Color fundus image, 2361x1568px, macula-centered, FOV: 50 degrees — 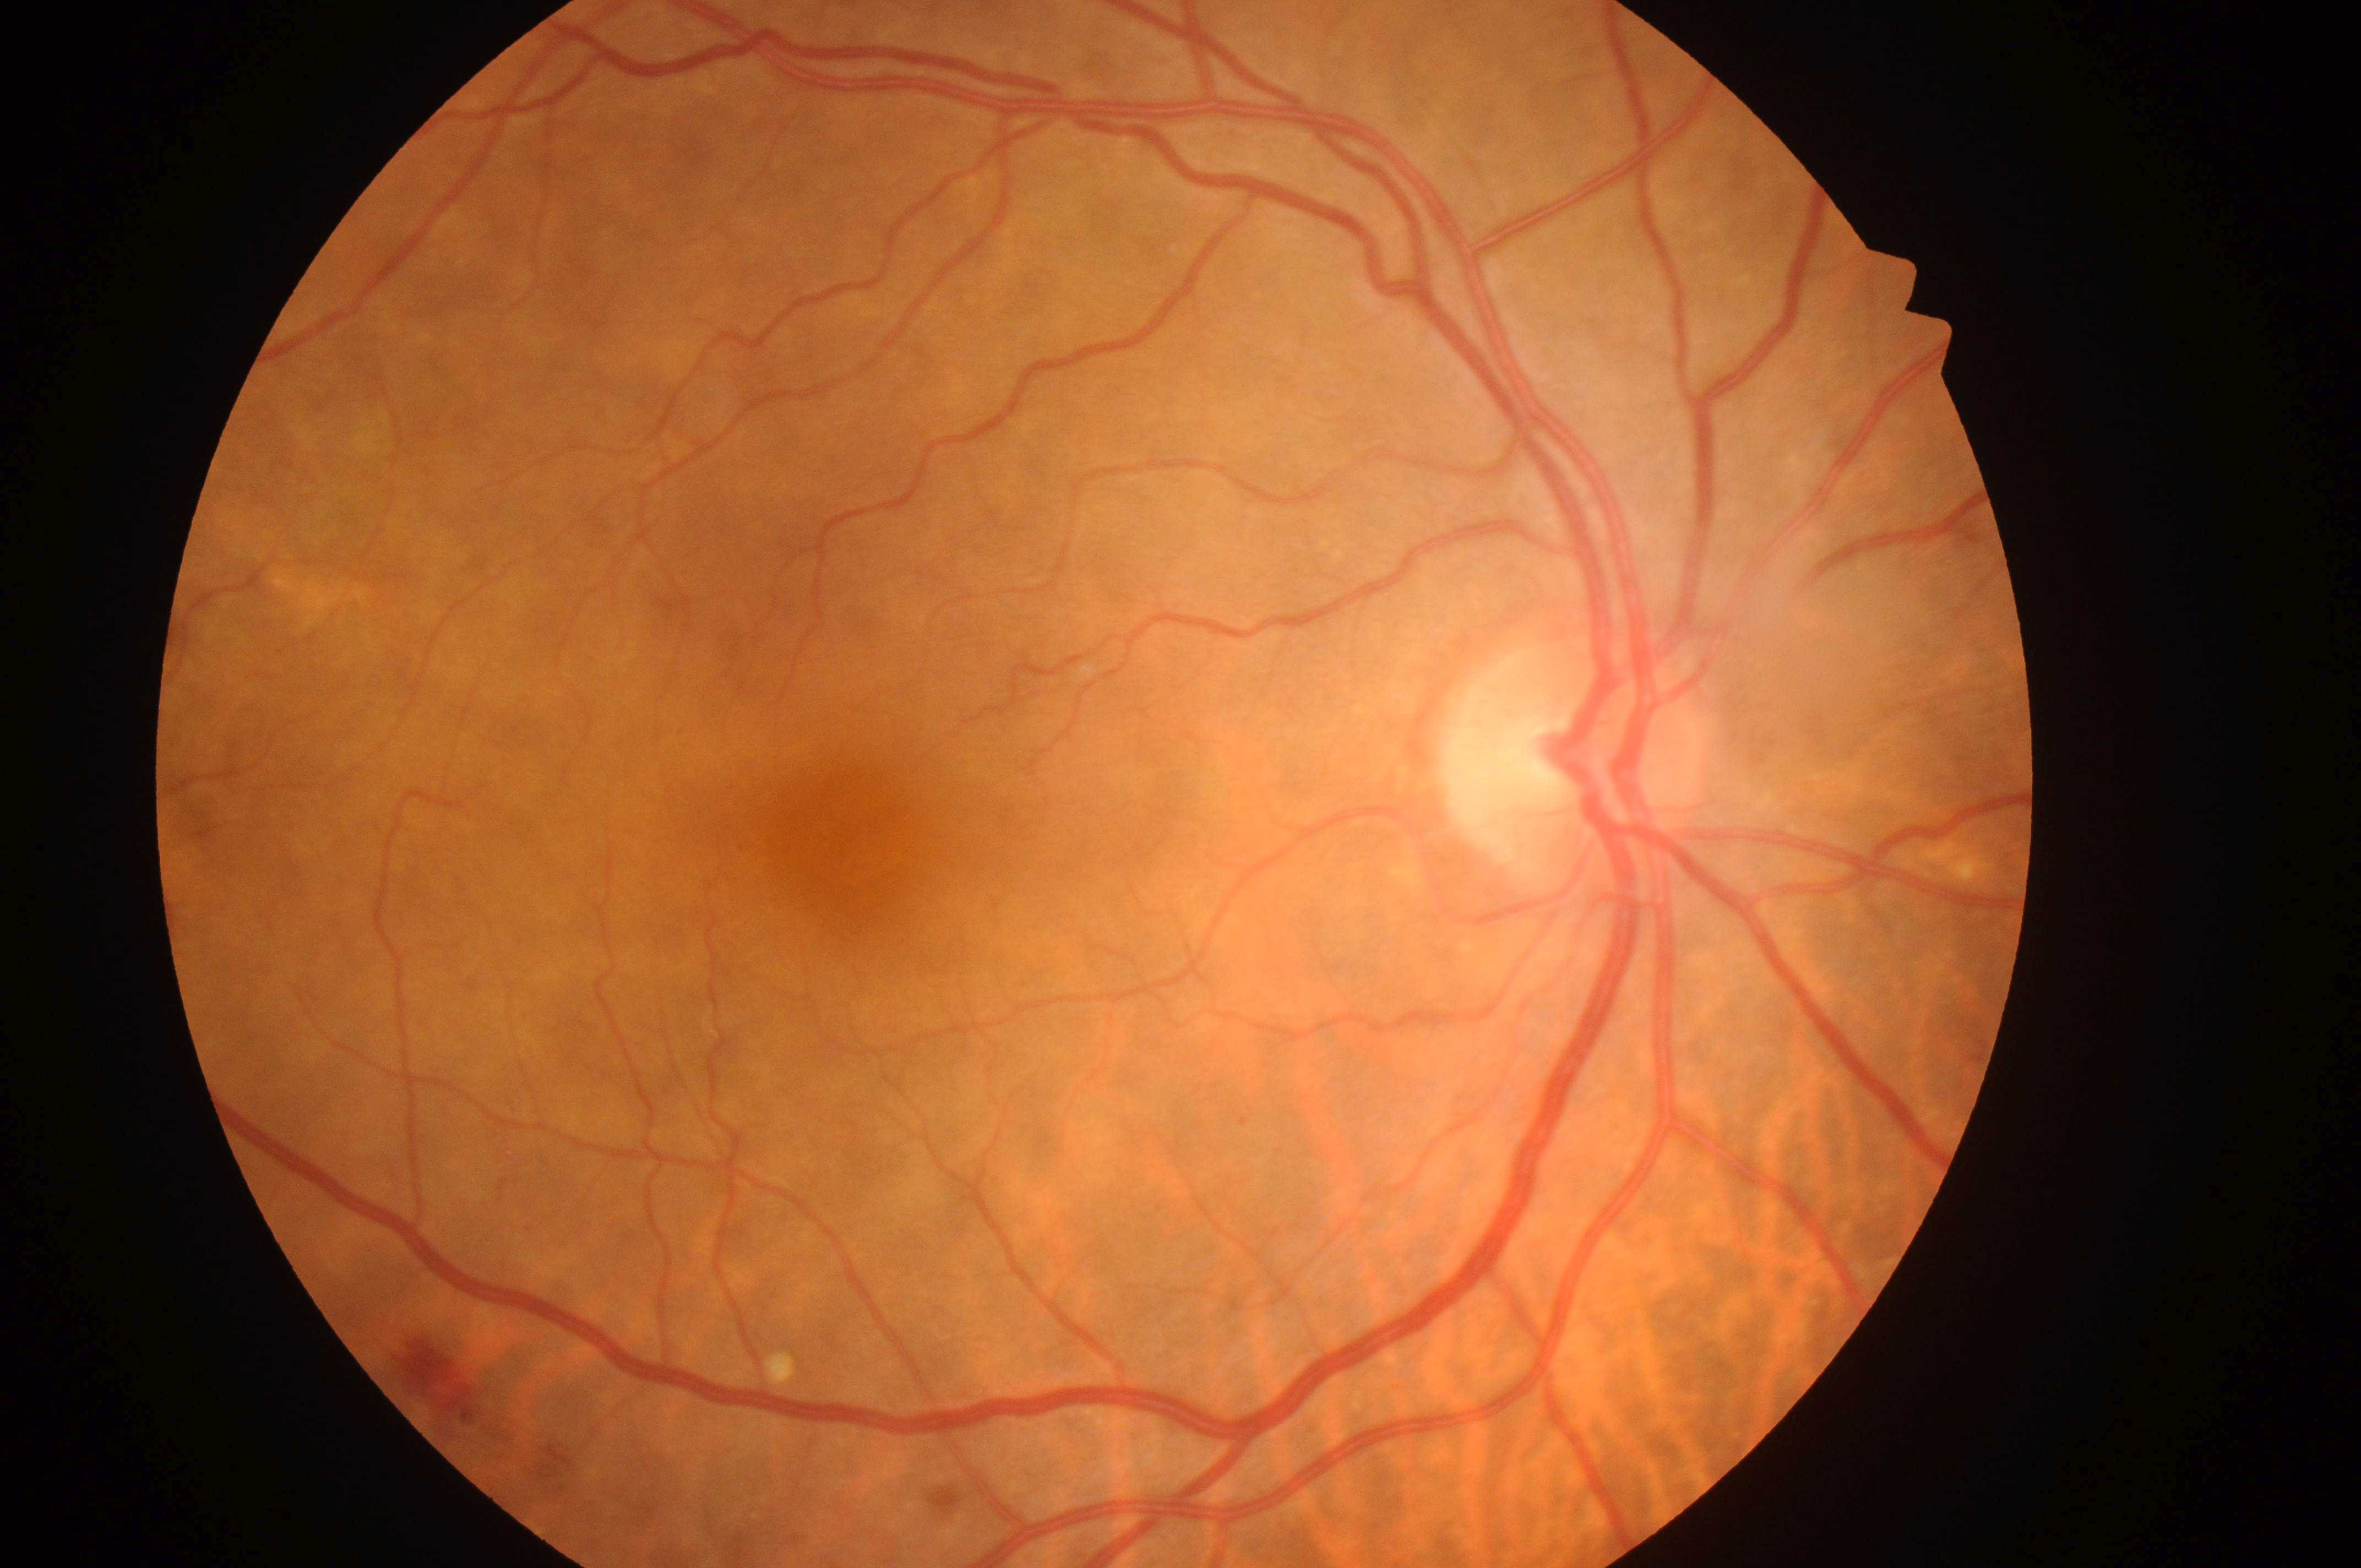

* DME risk · grade 0 (no risk)
* DR stage · moderate non-proliferative diabetic retinopathy (grade 2)
* laterality · oculus dexter
* fovea center · [846, 835]
* optic nerve head · [1555, 773]